FOV: 45 degrees: 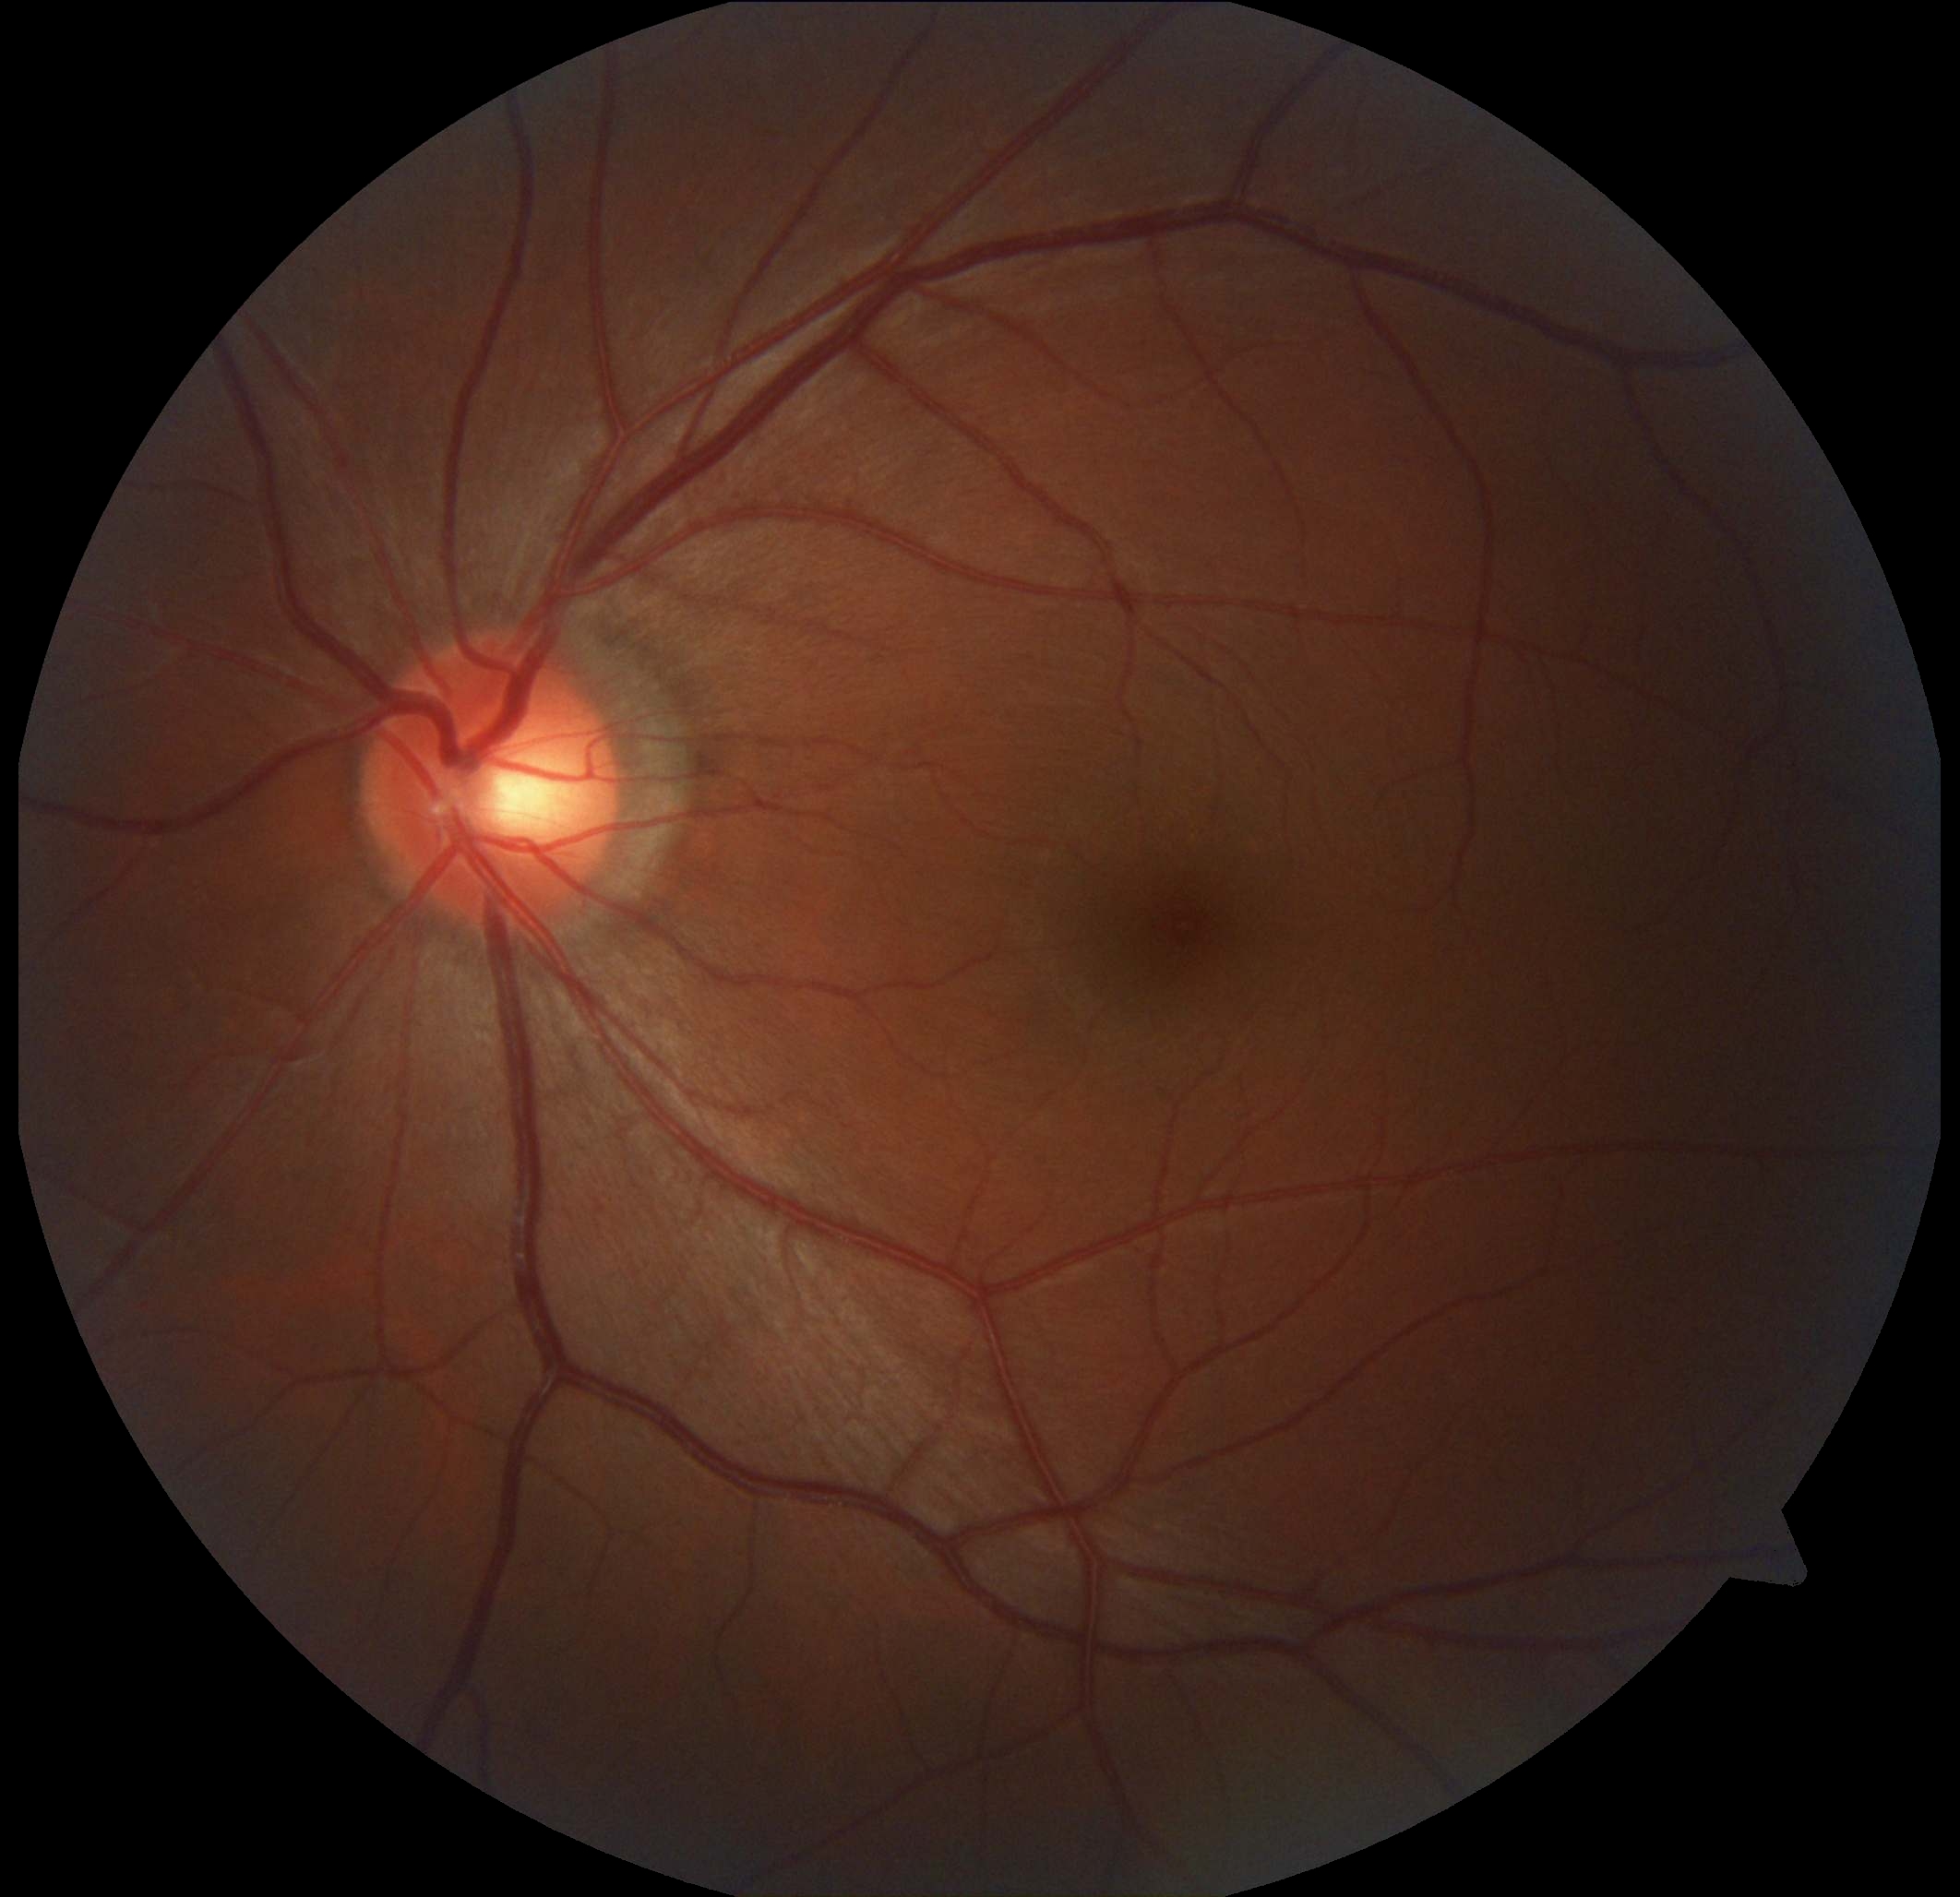
DR impression: no DR findings | DR: 0.